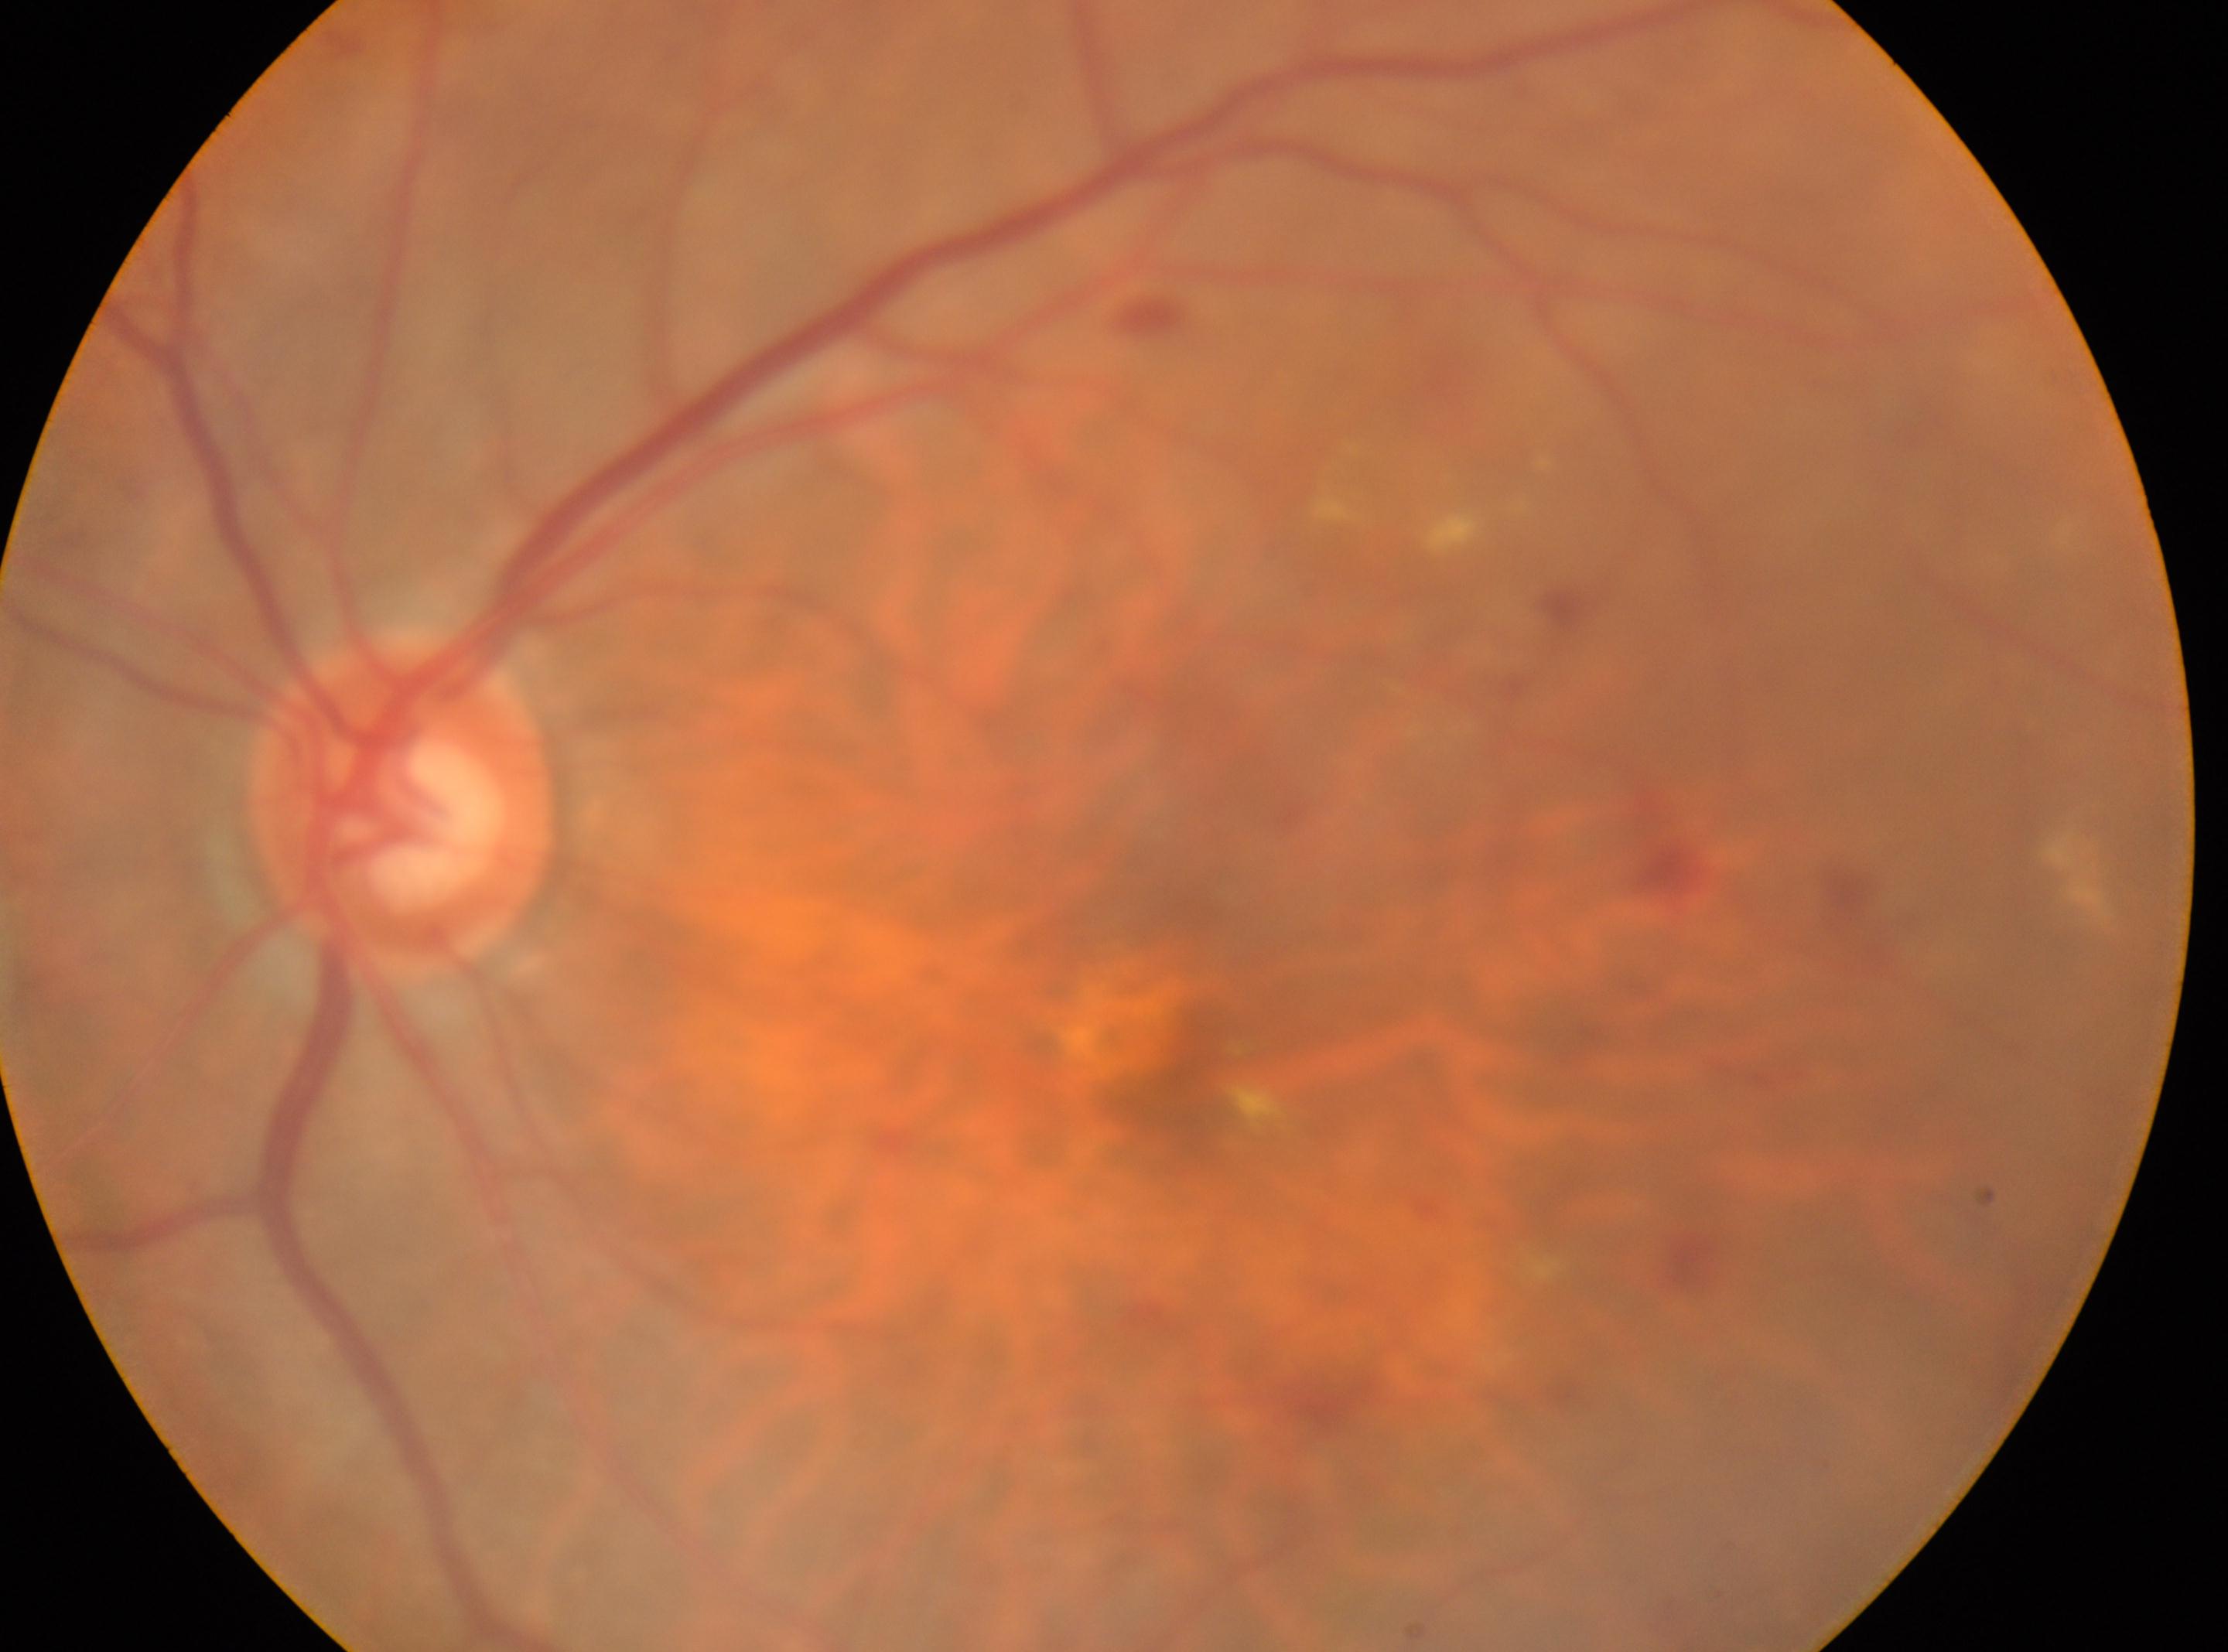
  dr_grade: 2 (moderate NPDR) — more than just microaneurysms but less than severe NPDR
  optic_disc: (x: 398, y: 807)
  eye: oculus sinister
  fovea: (x: 1171, y: 1087)